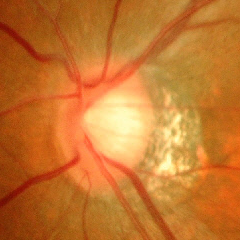

Glaucoma stage = advanced glaucomatous optic neuropathy.